2352x1568px; FOV: 45 degrees
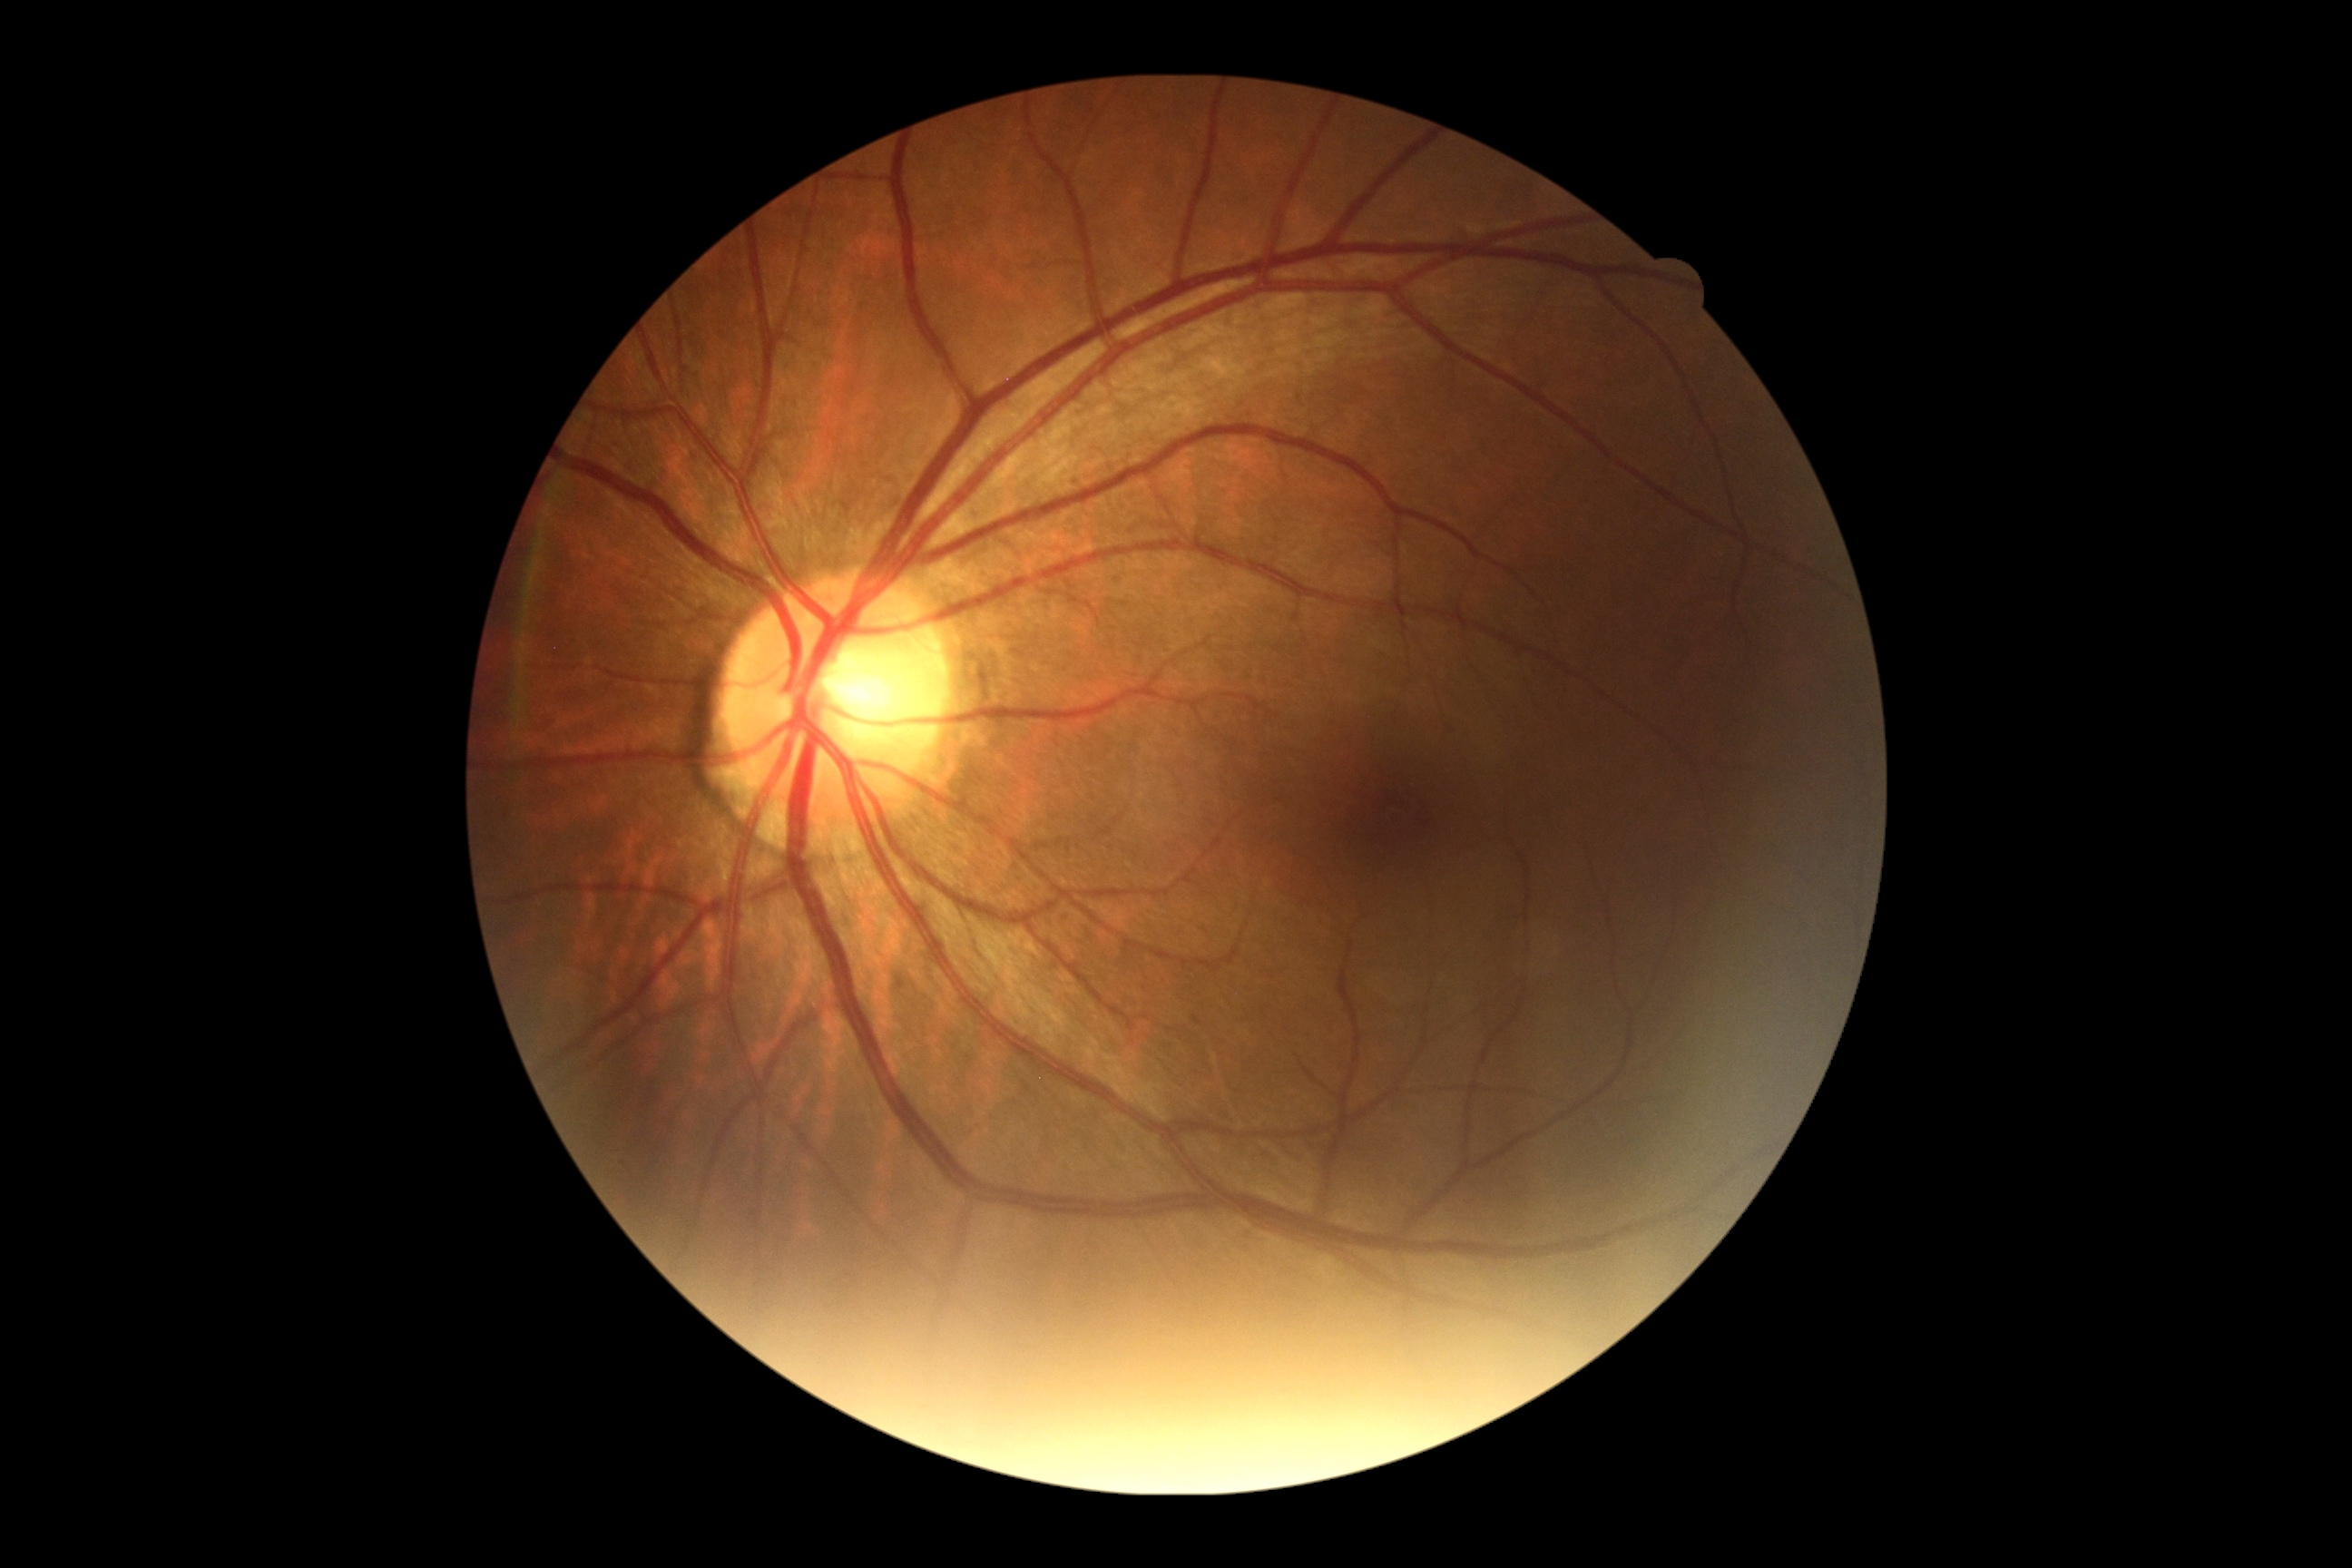
Diabetic retinopathy (DR) is 0. No DR findings.